Ultra-widefield (UWF) fundus image: 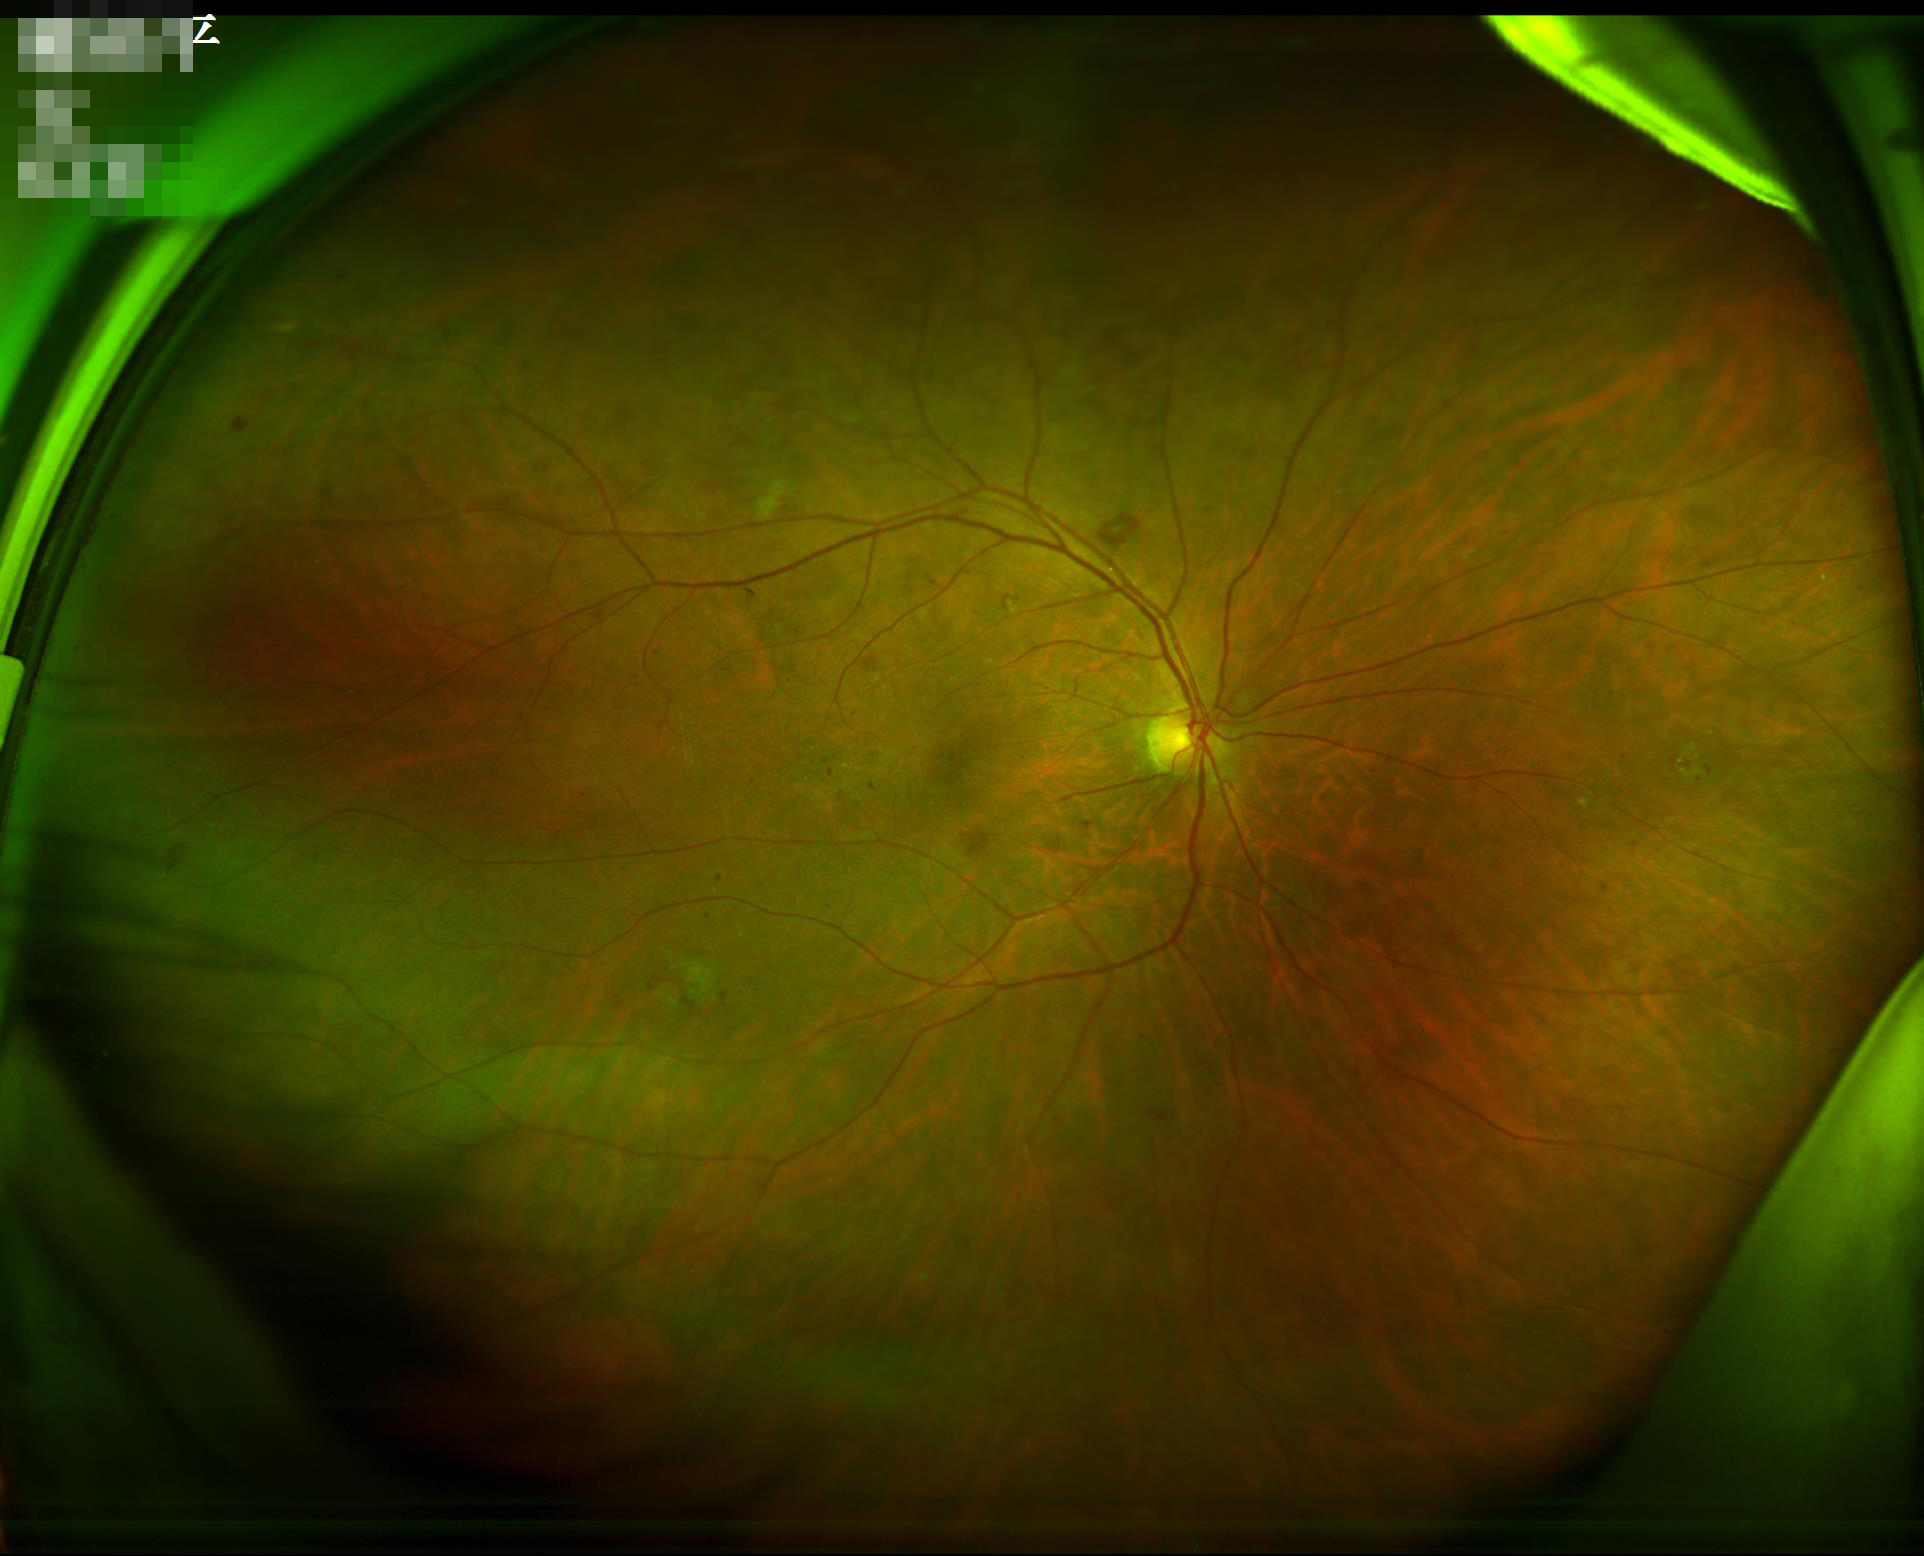
Image quality is adequate for diagnostic use.
No over- or under-exposure.
Contrast is good.
Image is sharp throughout the field.